Pediatric retinal photograph (wide-field); Phoenix ICON, 100° FOV — 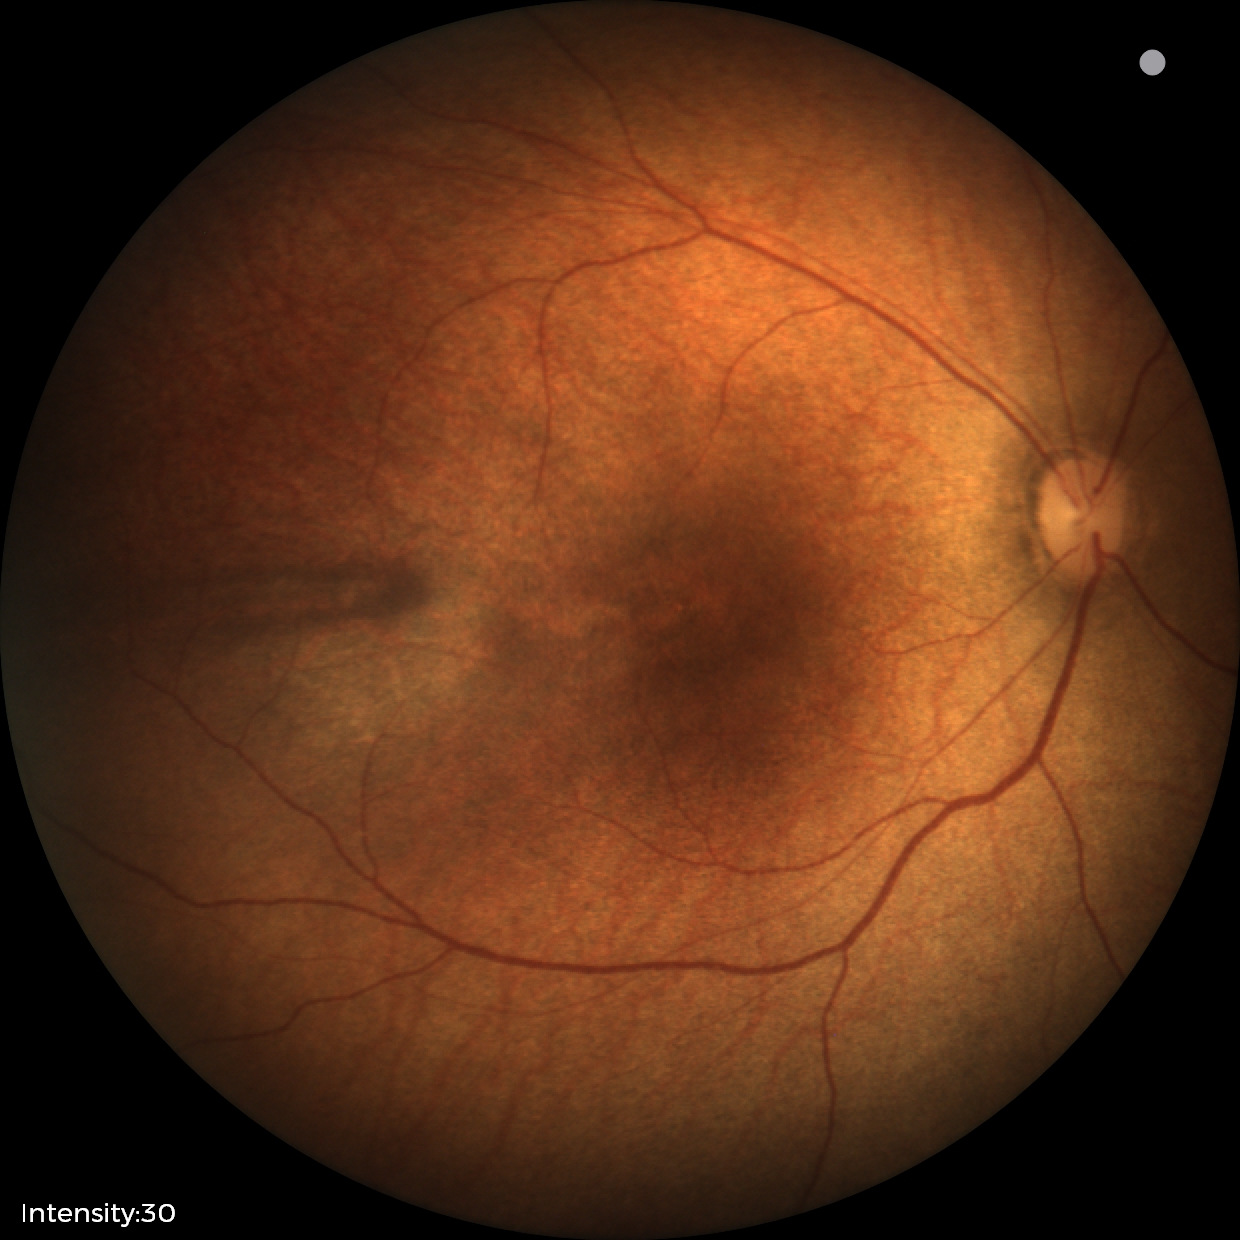
Screening examination with no abnormal retinal findings.